CFP, modified Davis grading.
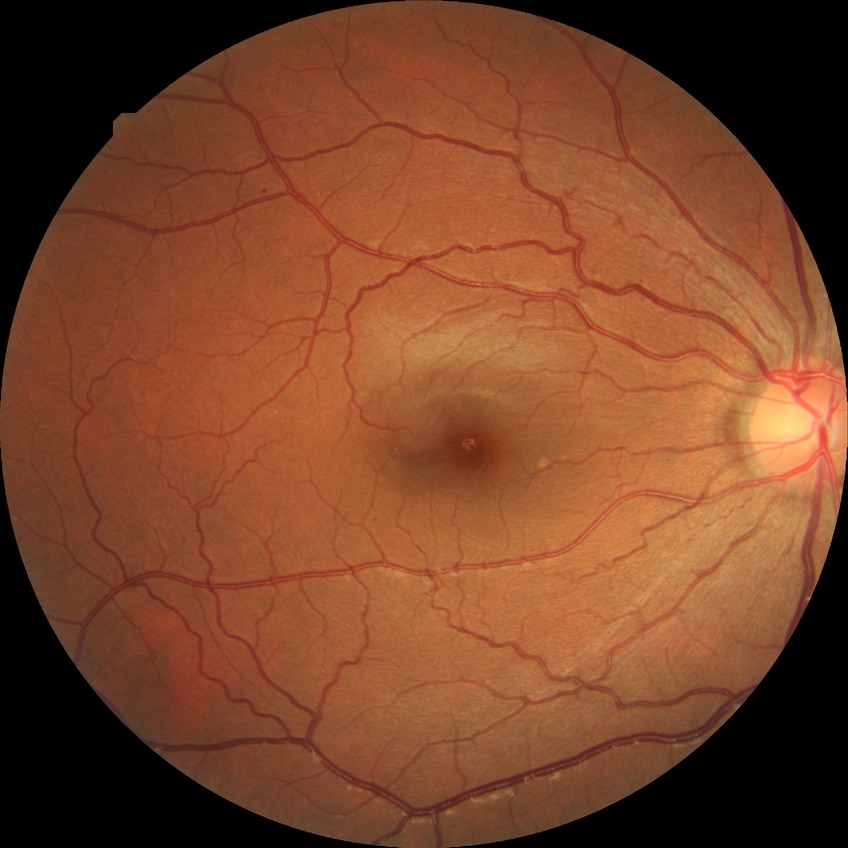 diabetic retinopathy (DR): simple diabetic retinopathy (SDR).